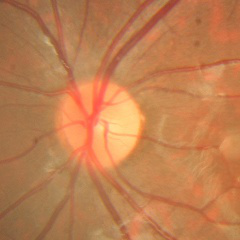 This fundus photograph shows no signs of glaucoma.